Image size 2212x1672: 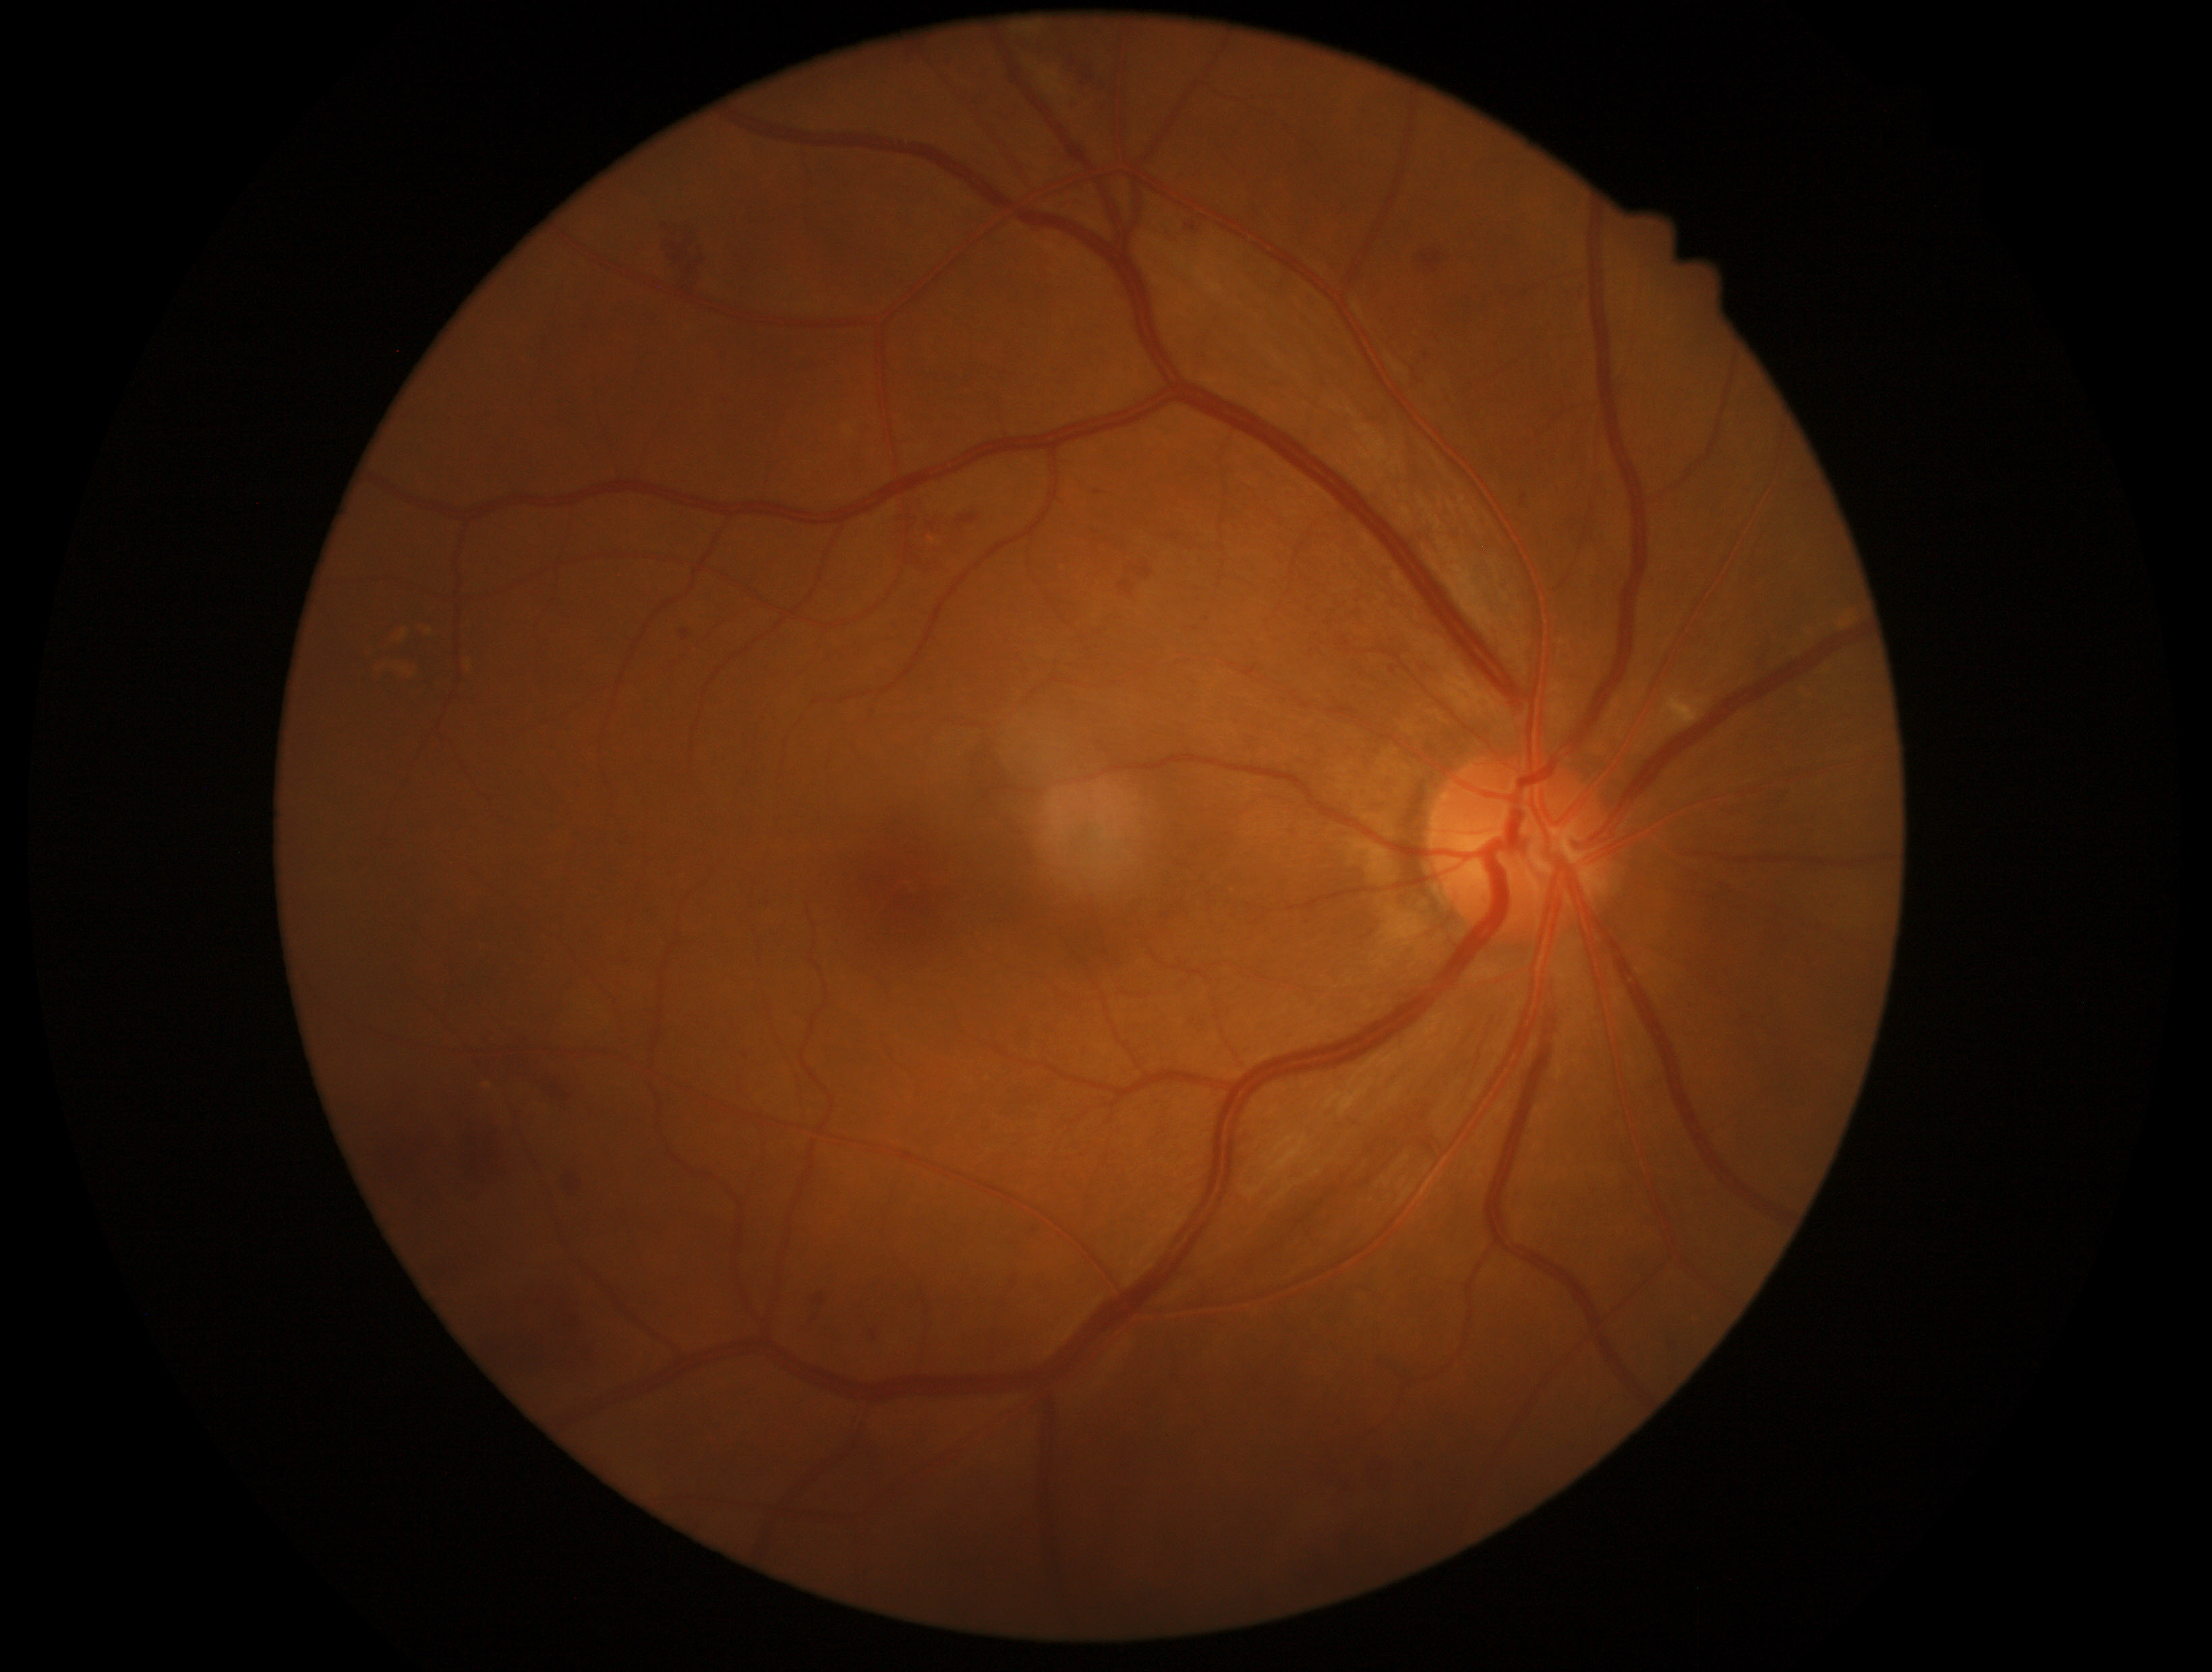

Diabetic retinopathy grade is 2/4.